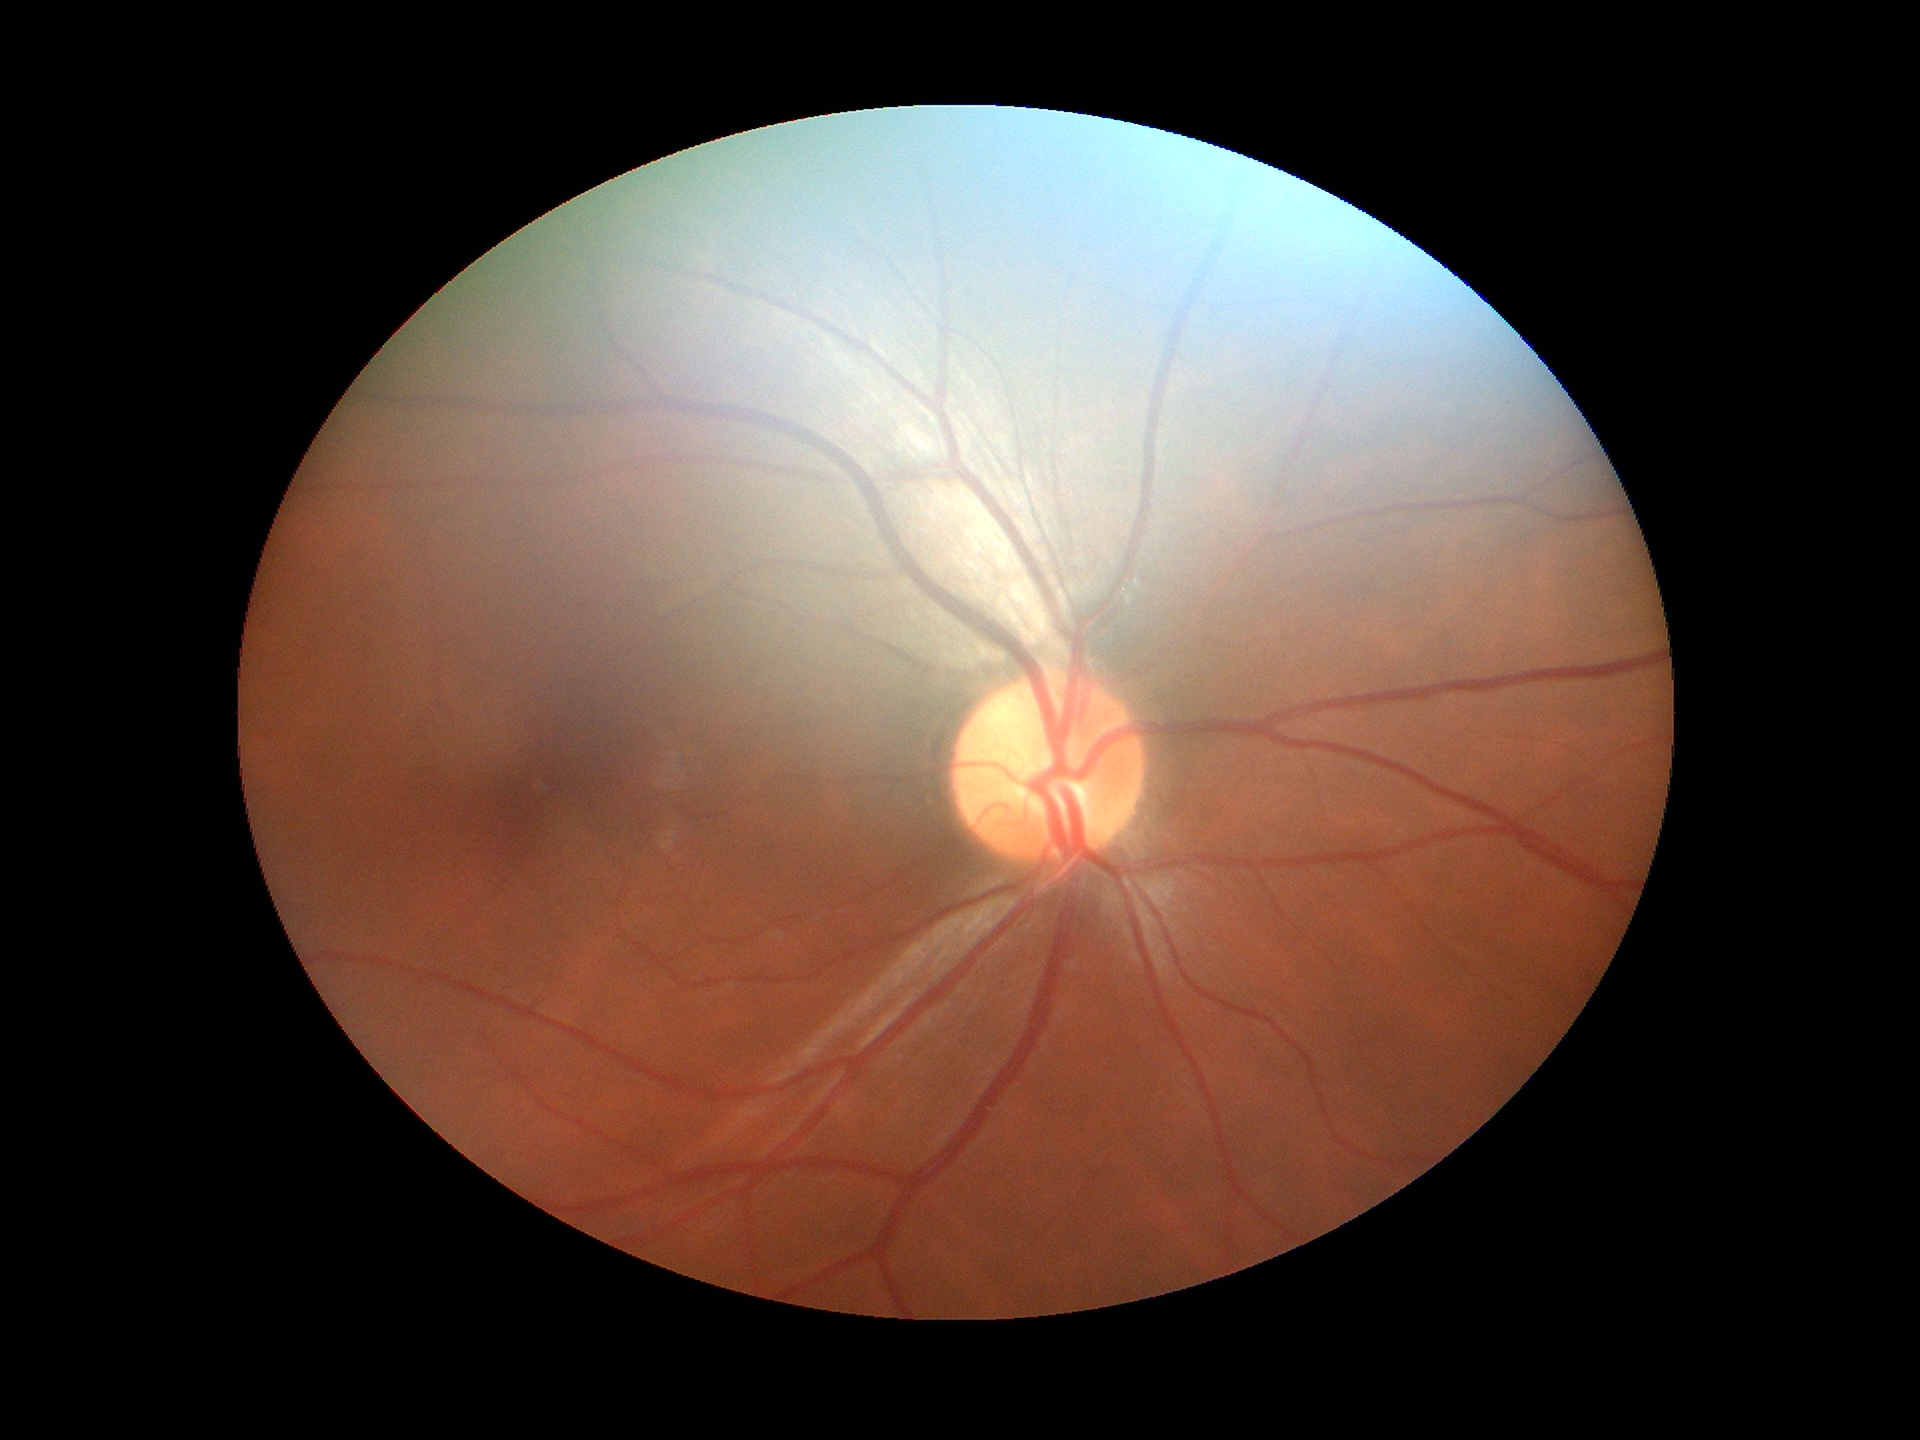
vertical cup-disc ratio (VCDR) = 0.46; area CDR (ACDR) = 0.22; Glaucoma assessment = not suspect (all 5 graders called normal).